1240 x 1240 pixels · pediatric retinal photograph (wide-field):
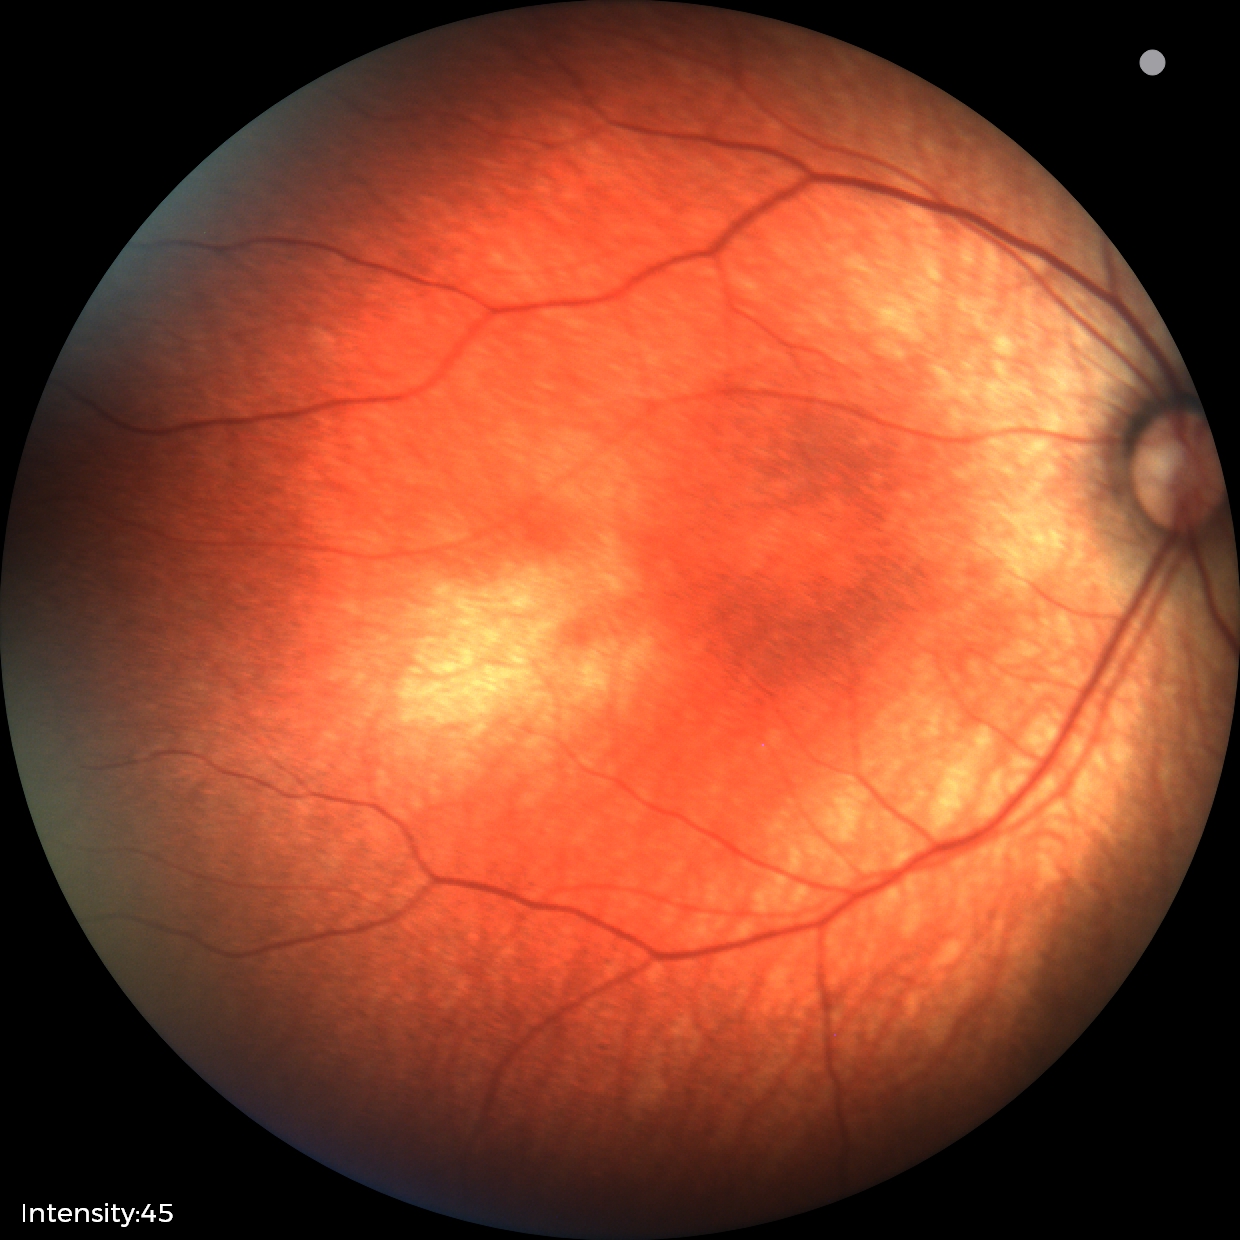 Finding: normal retinal appearance.